2089x1764 — 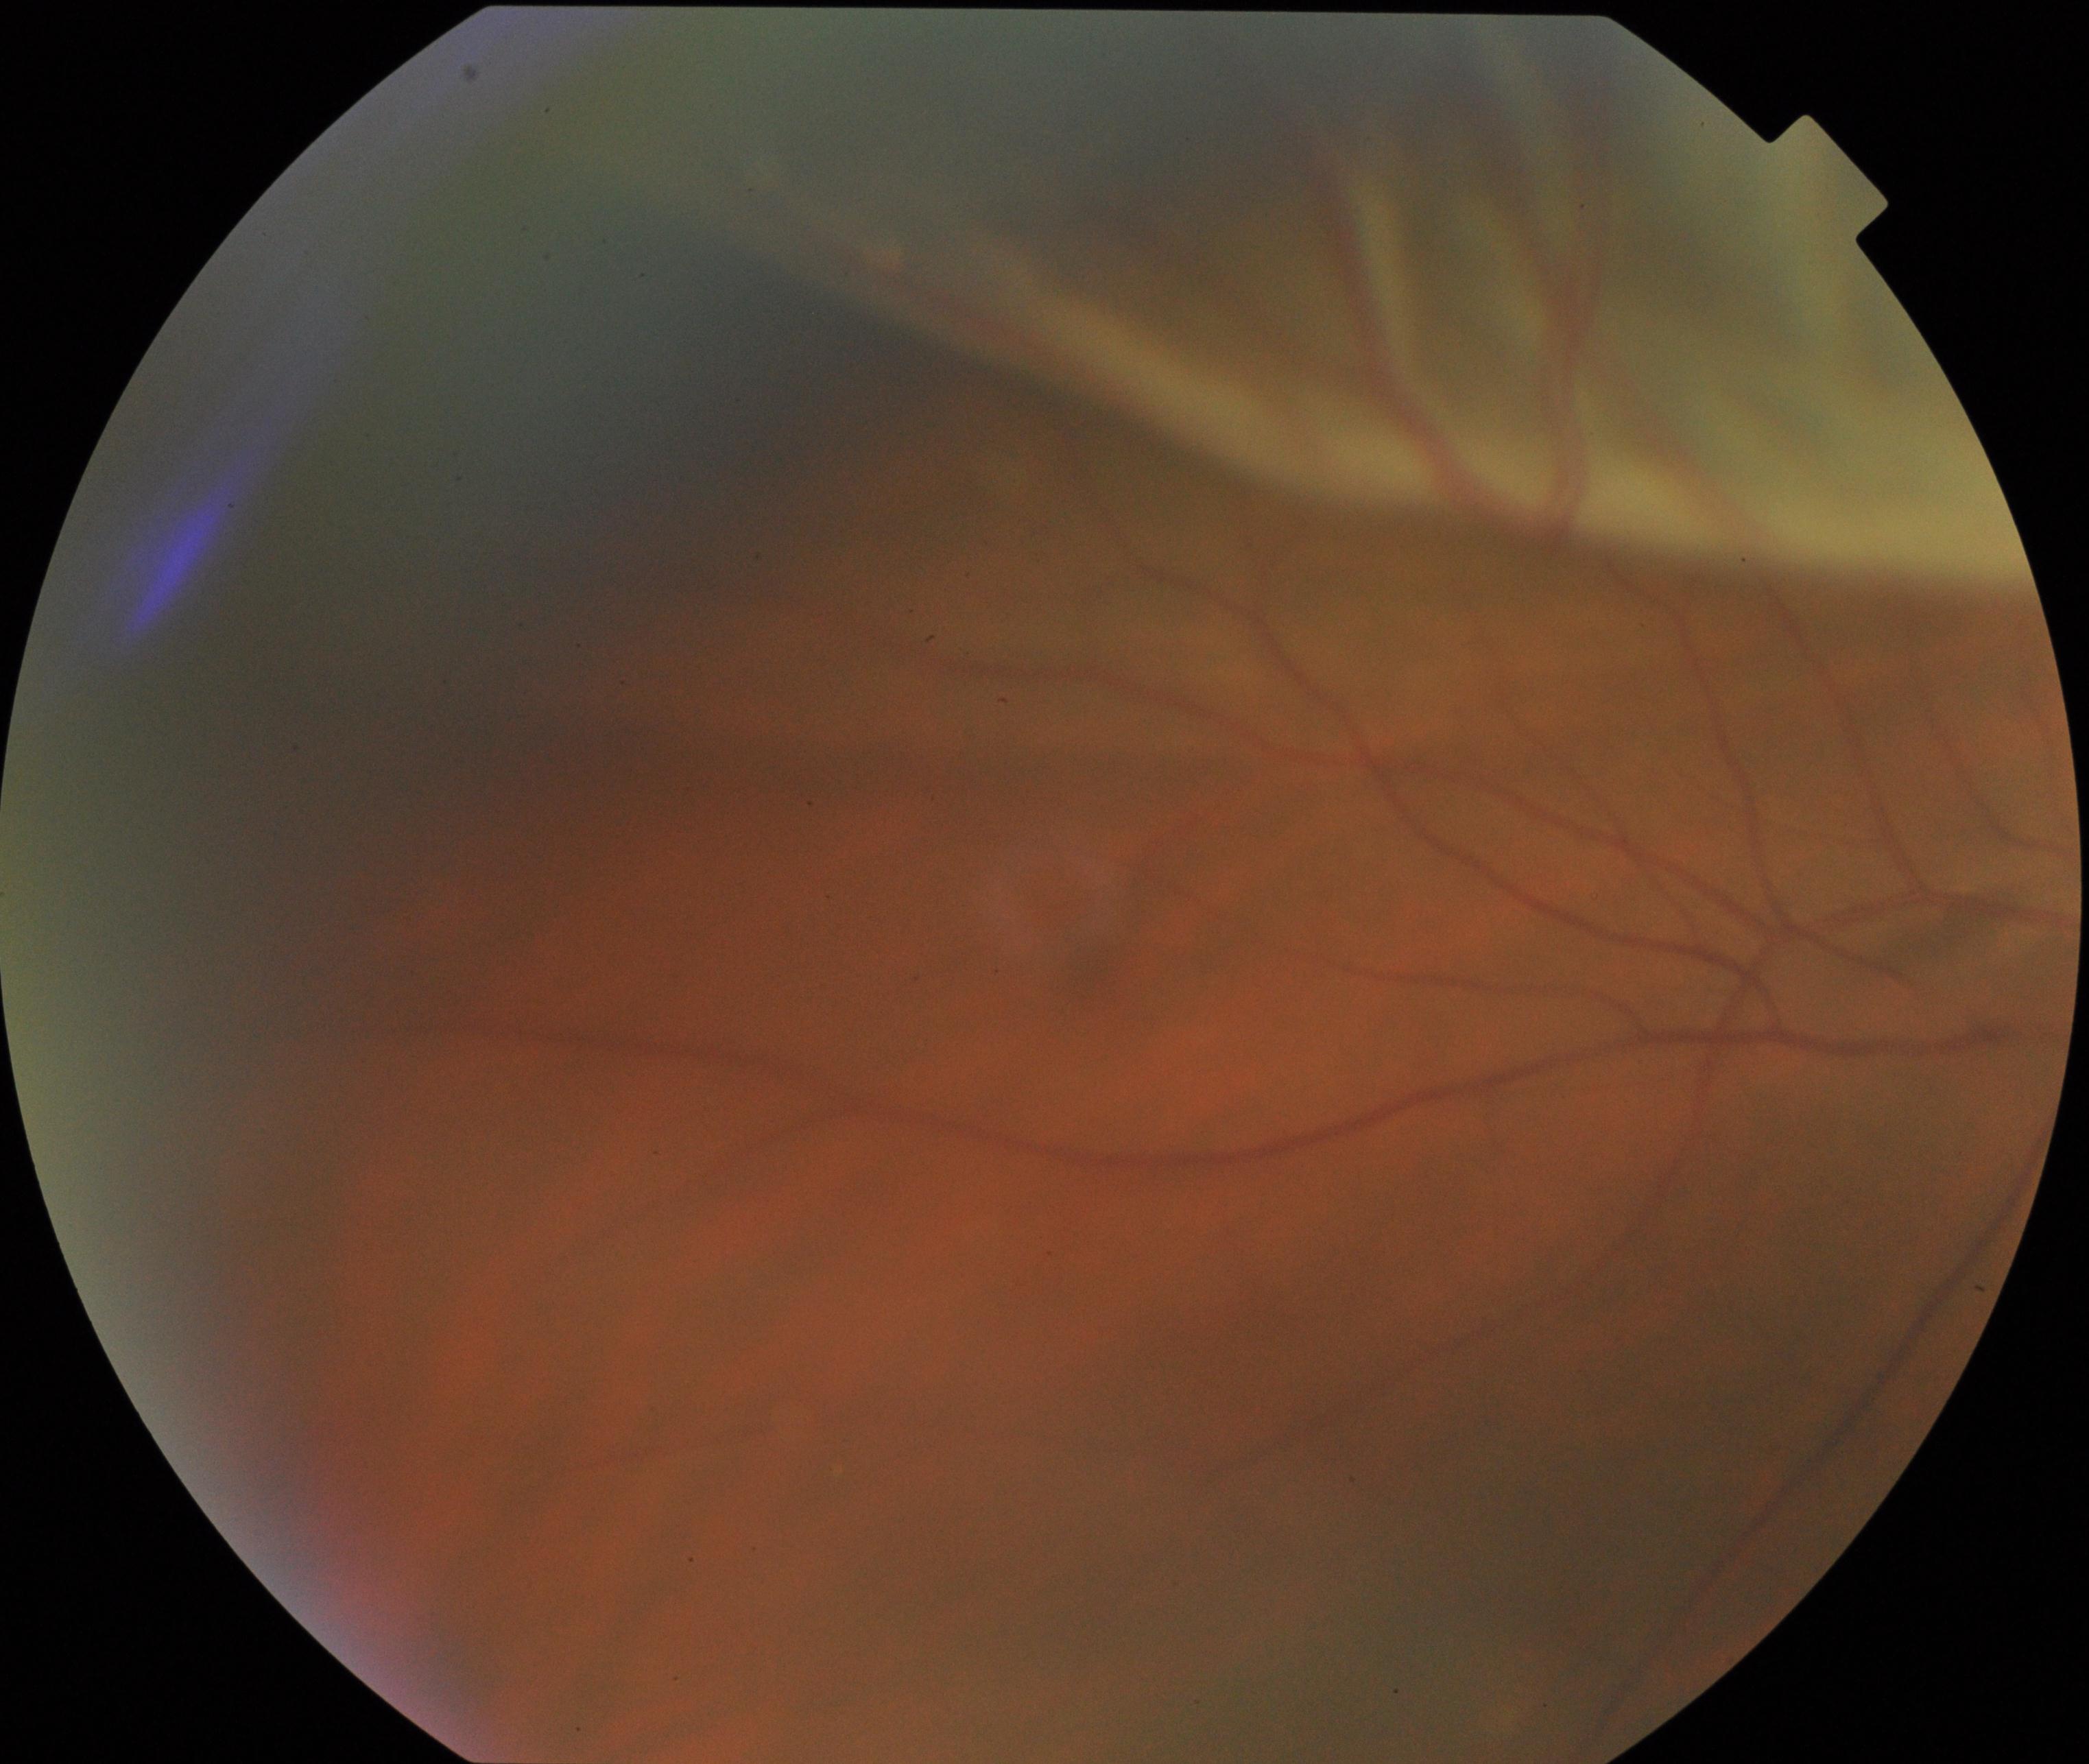
Diagnosis: rhegmatogenous retinal detachment.